640x480 · pediatric retinal photograph (wide-field): 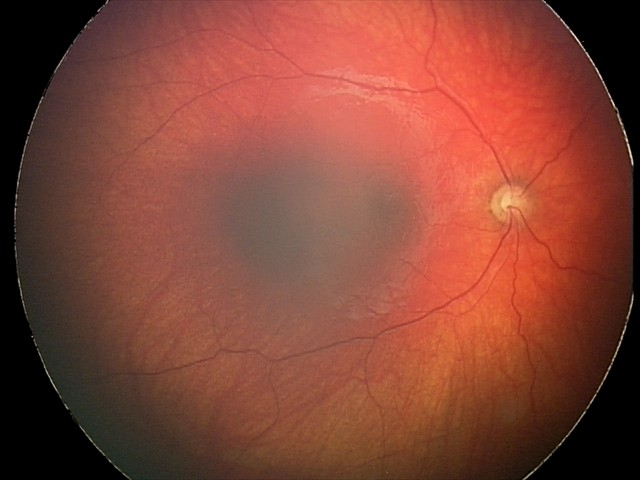

Diagnosis: optic nerve hypoplasia.